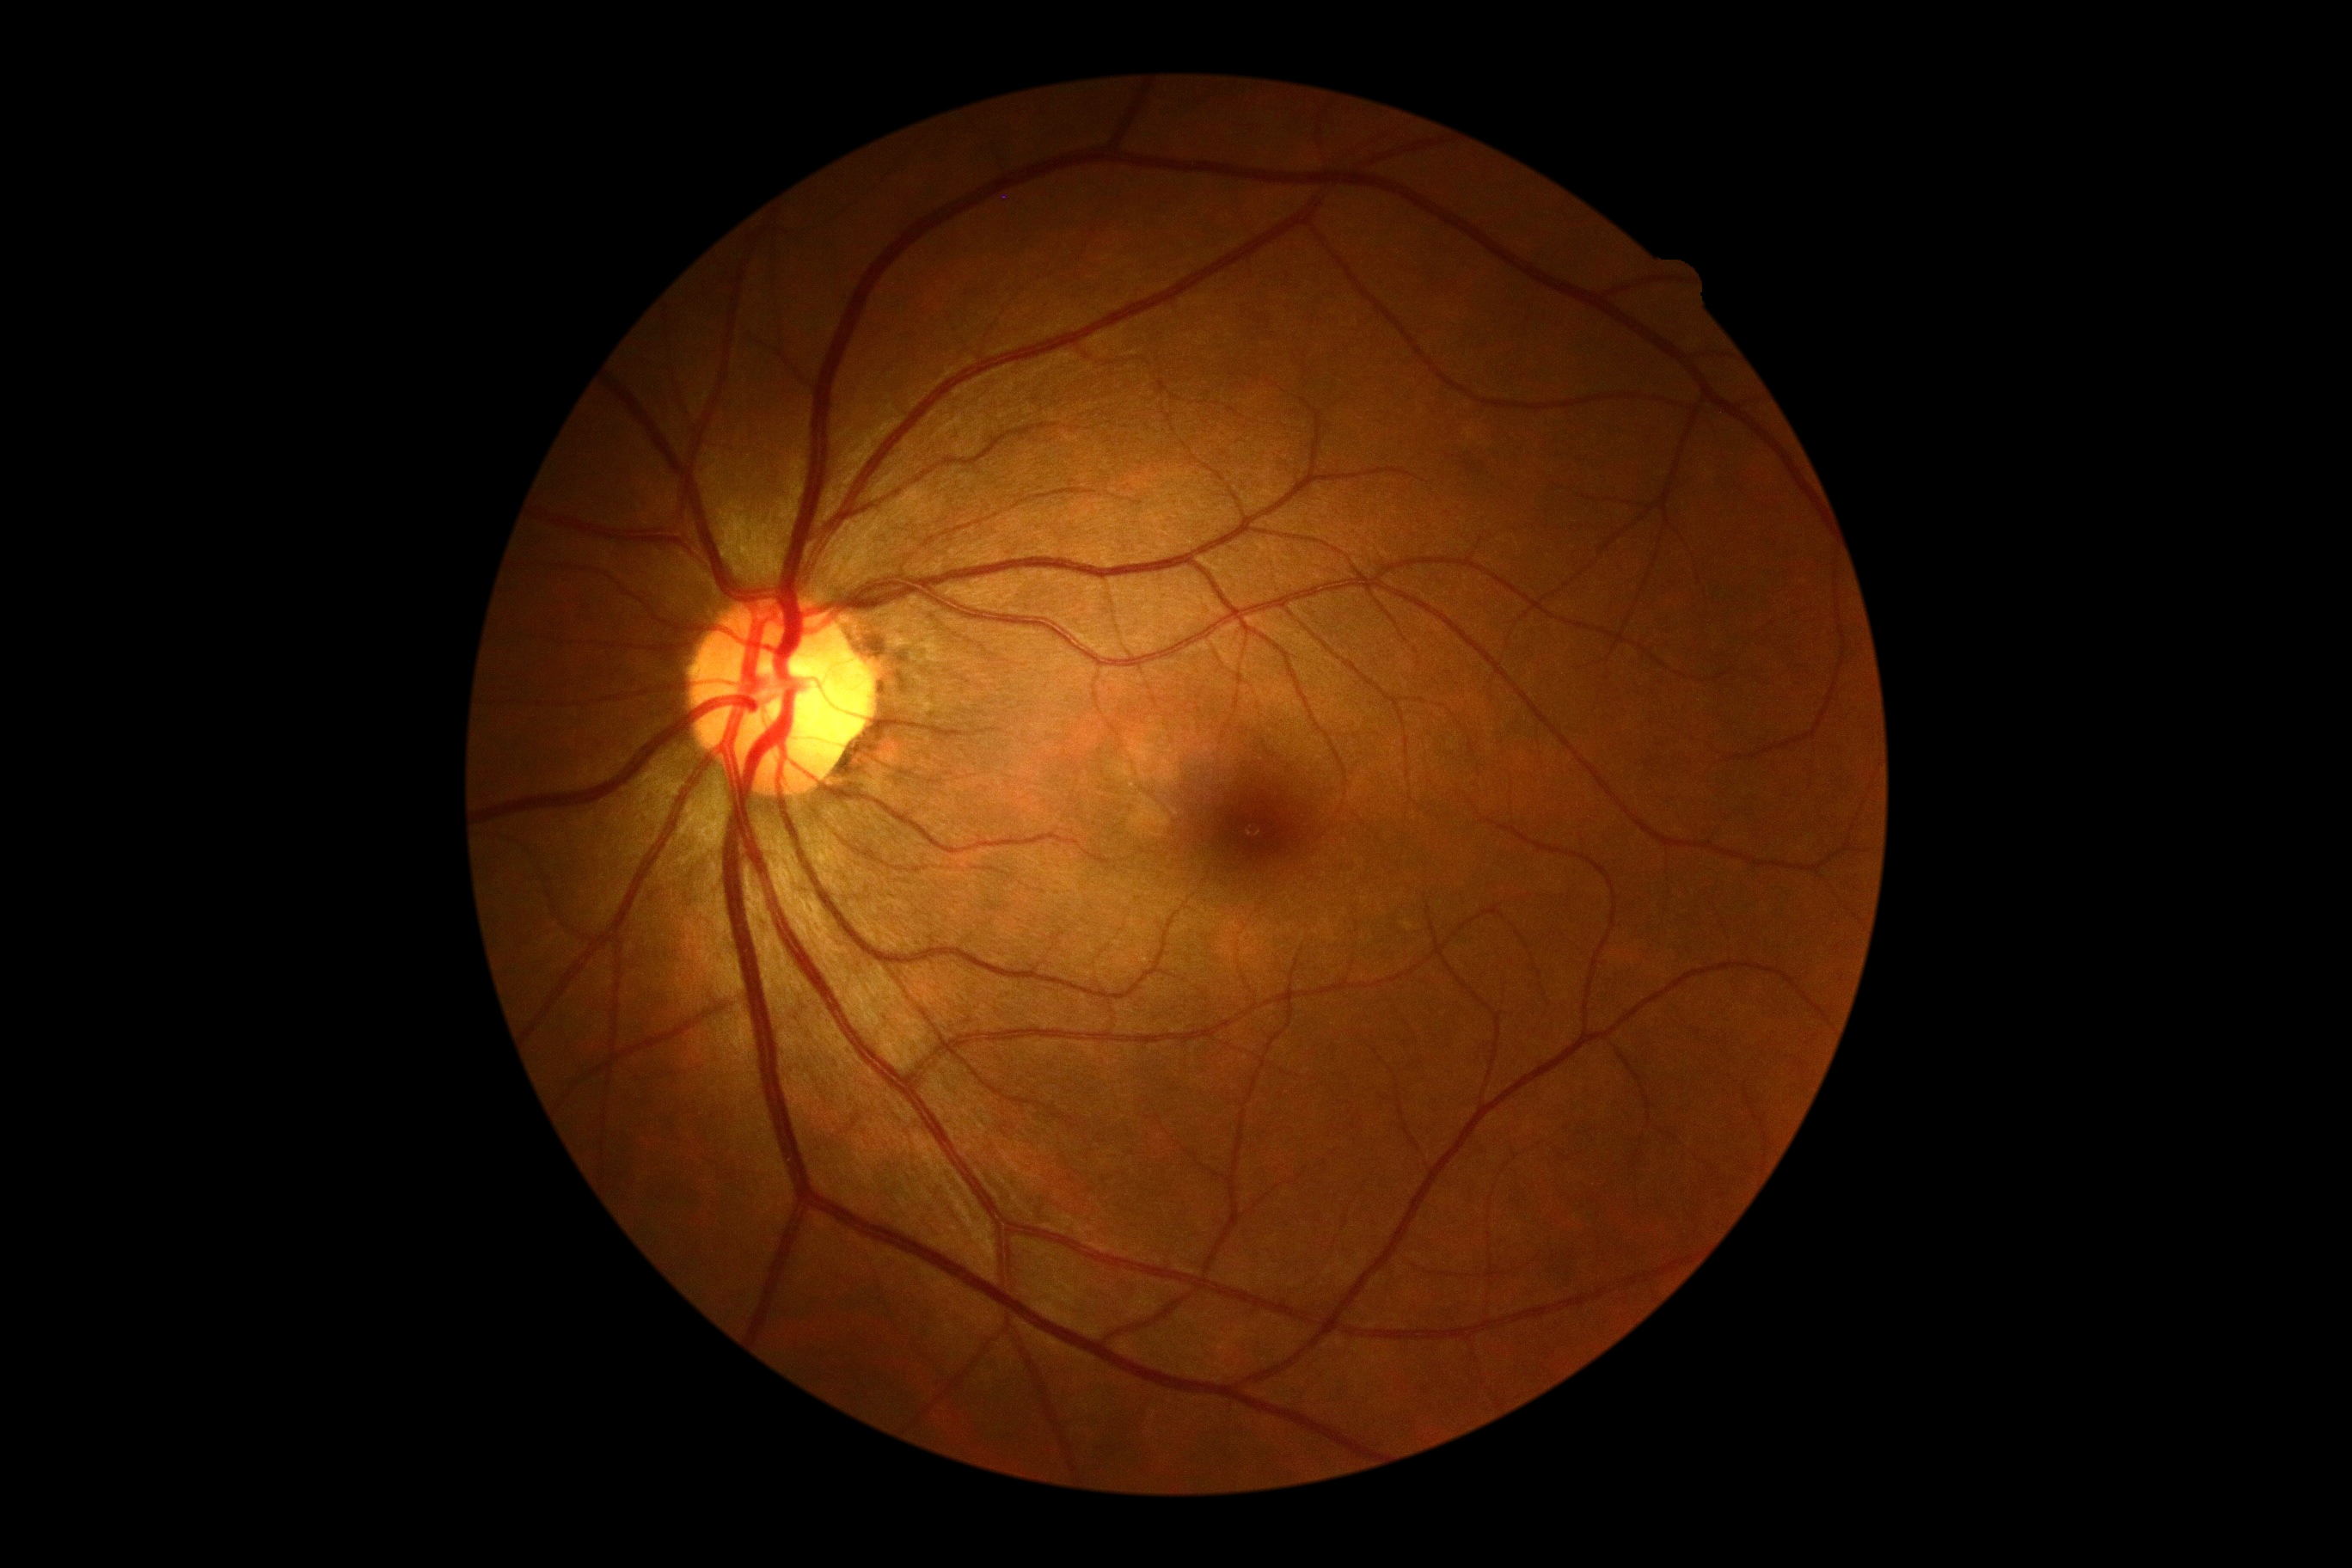

dr_grade: no apparent diabetic retinopathy (grade 0)